Camera: Natus RetCam Envision (130° FOV); infant wide-field retinal image — 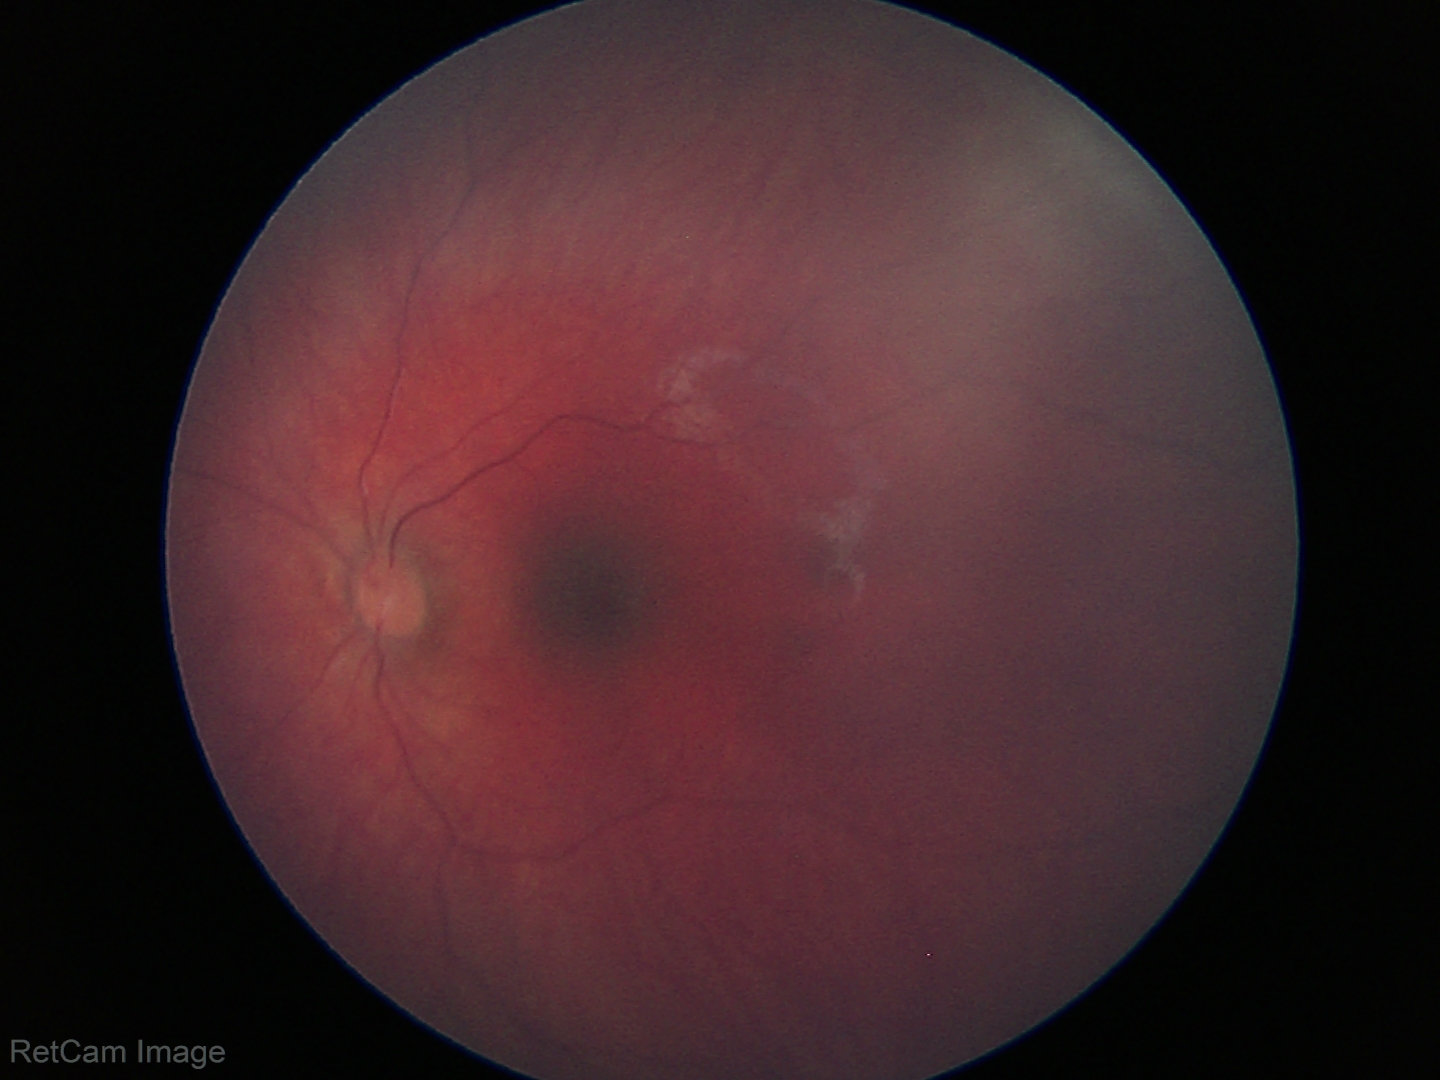 No retinal pathology identified on screening.